Wide-field fundus photograph from neonatal ROP screening — 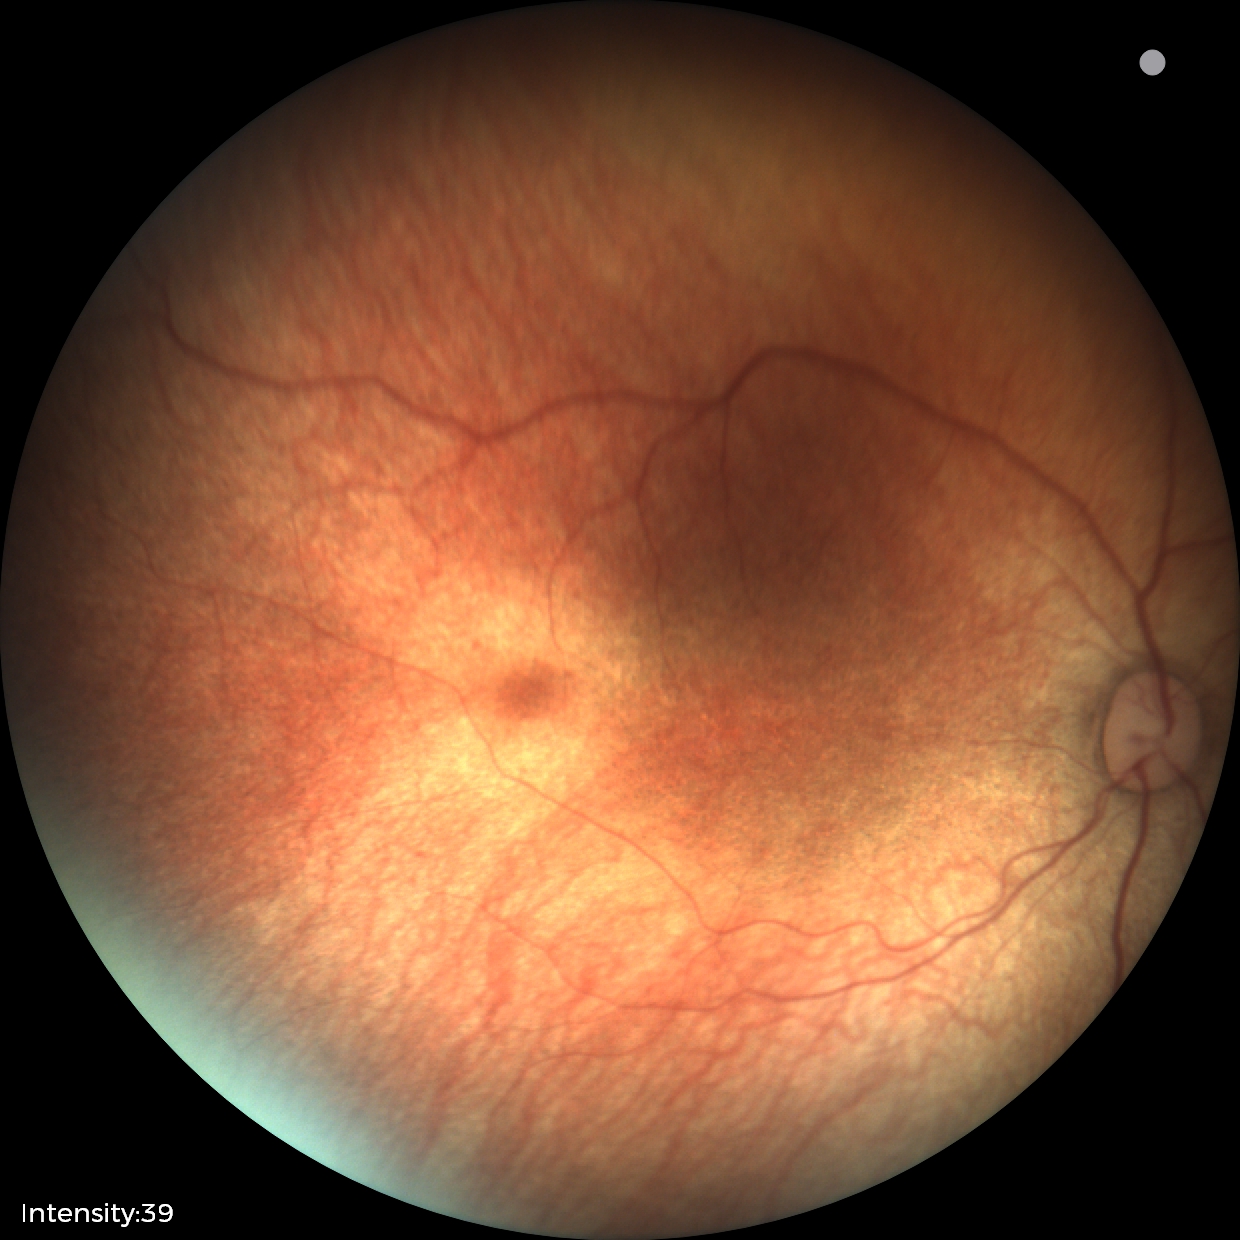
Screening examination diagnosed as physiological.